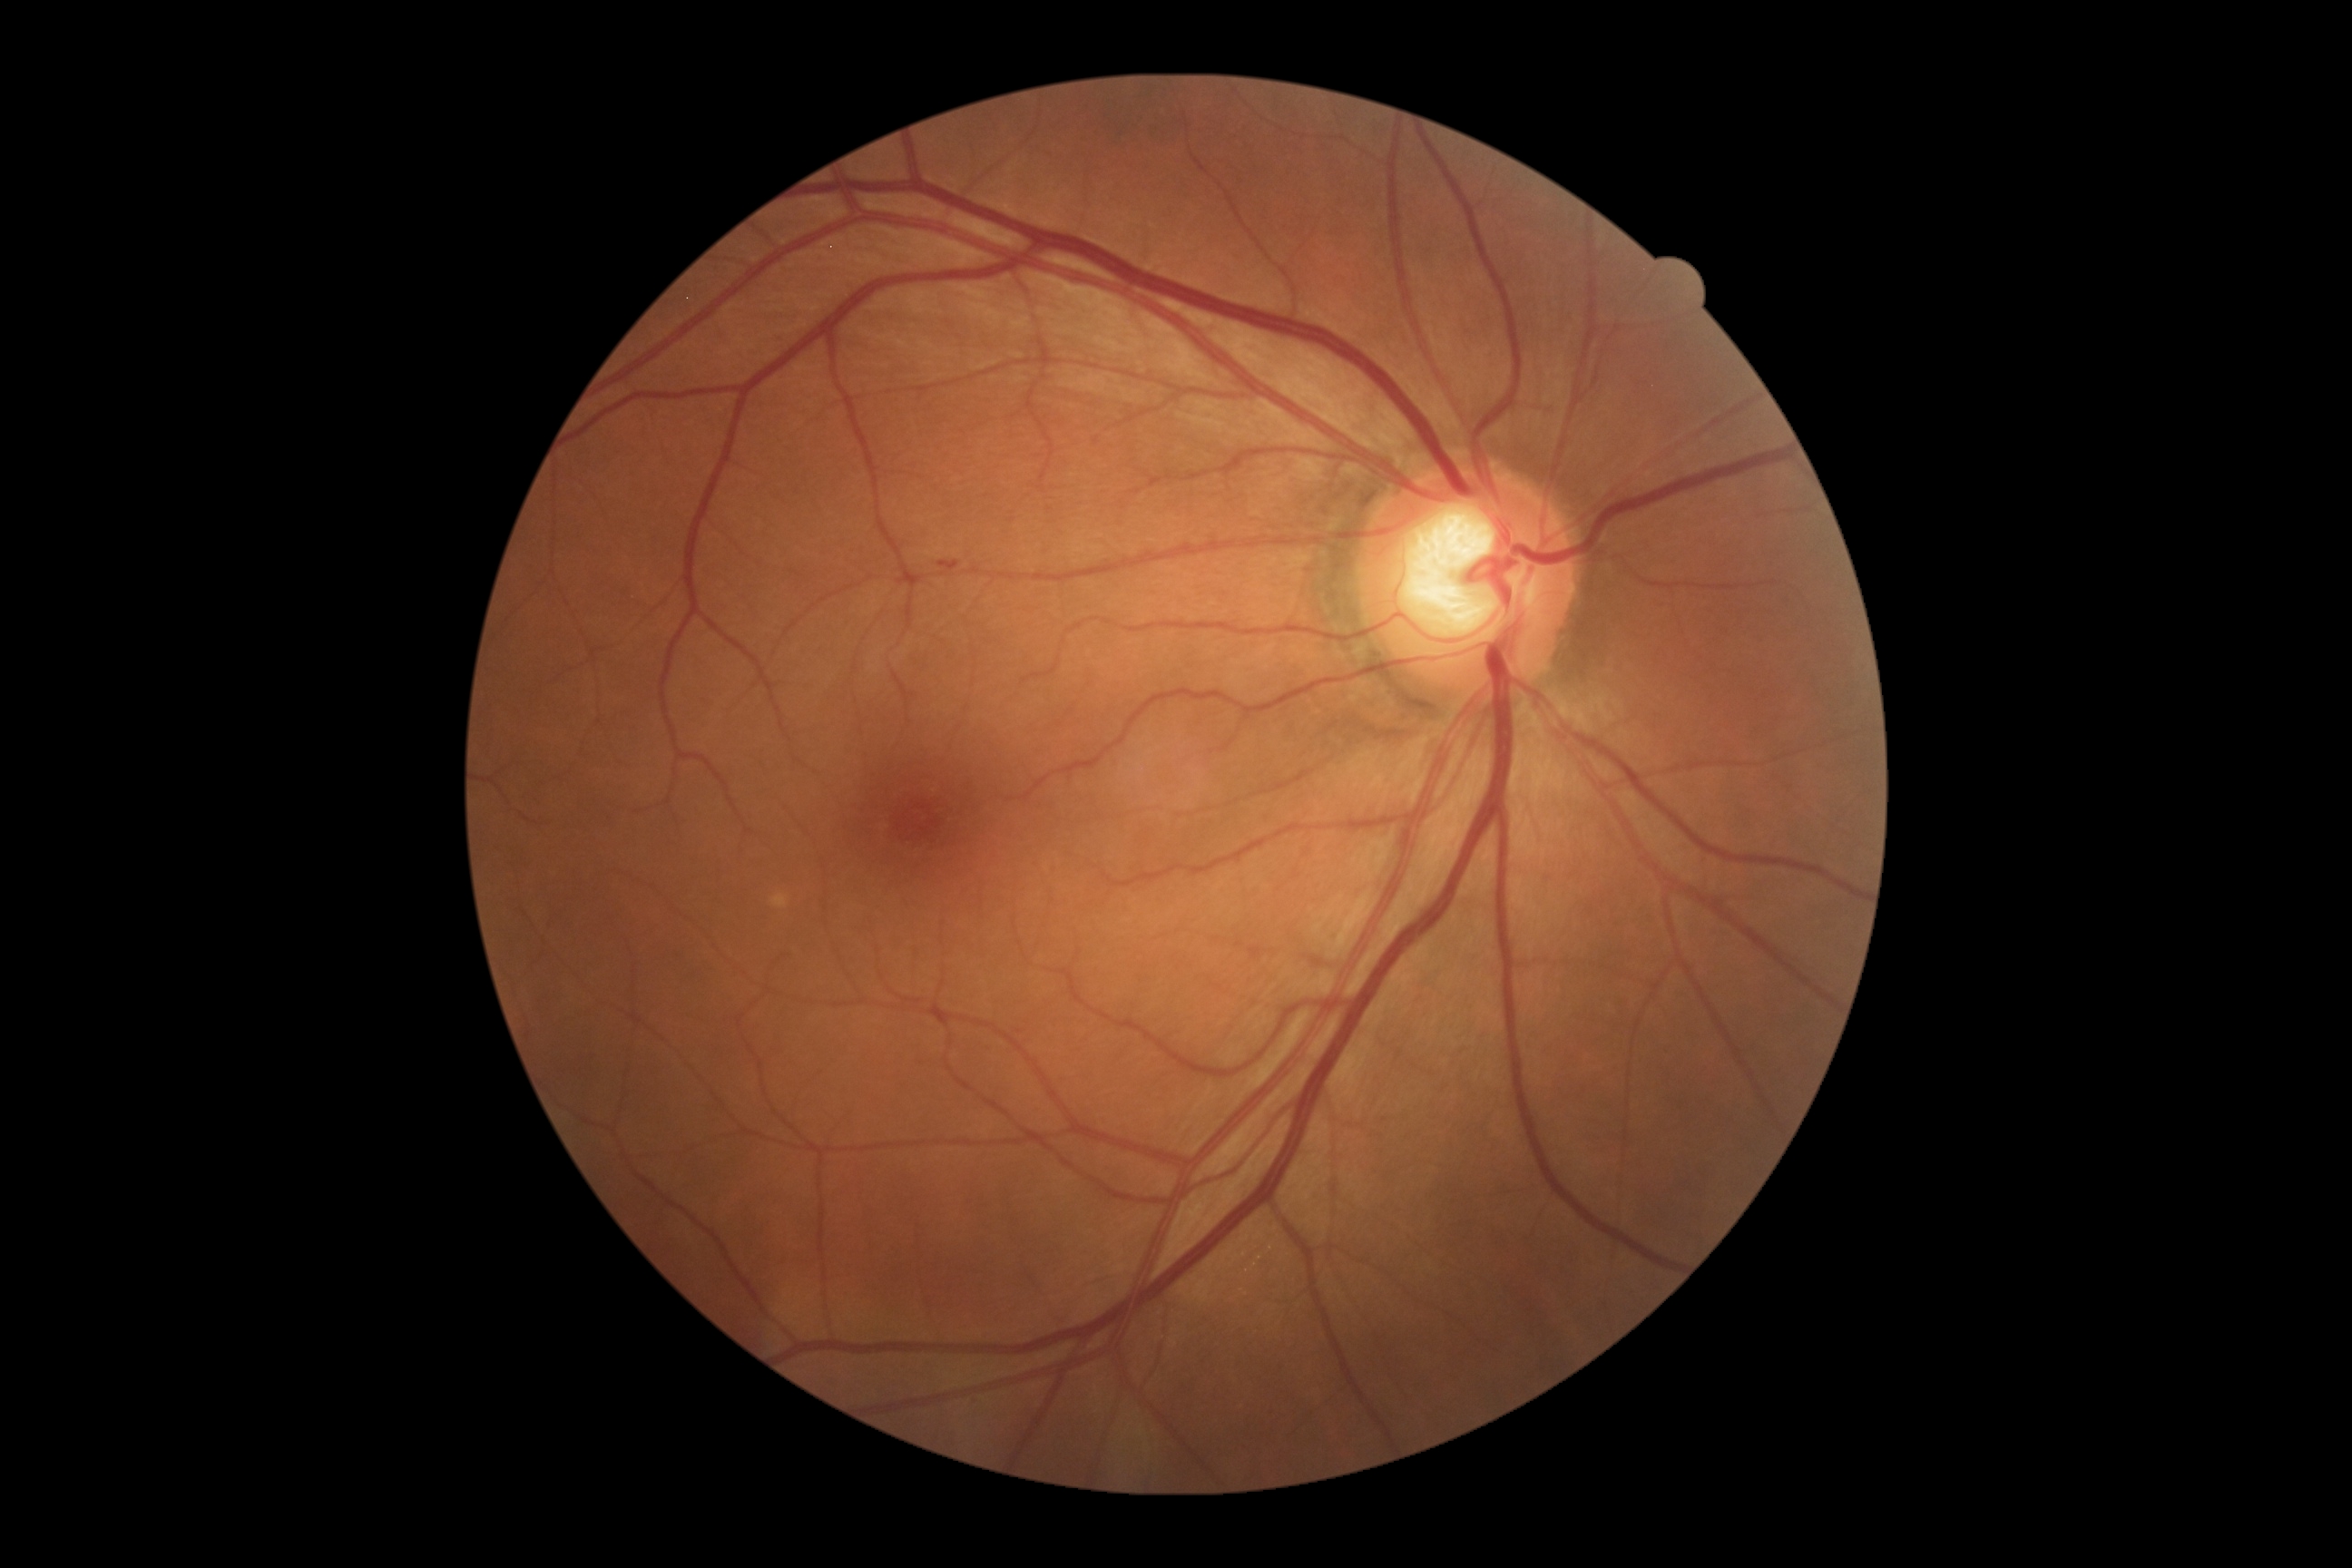
The retinopathy is classified as non-proliferative diabetic retinopathy. Retinopathy: grade 1.